2352 by 1568 pixels. Retinal fundus photograph
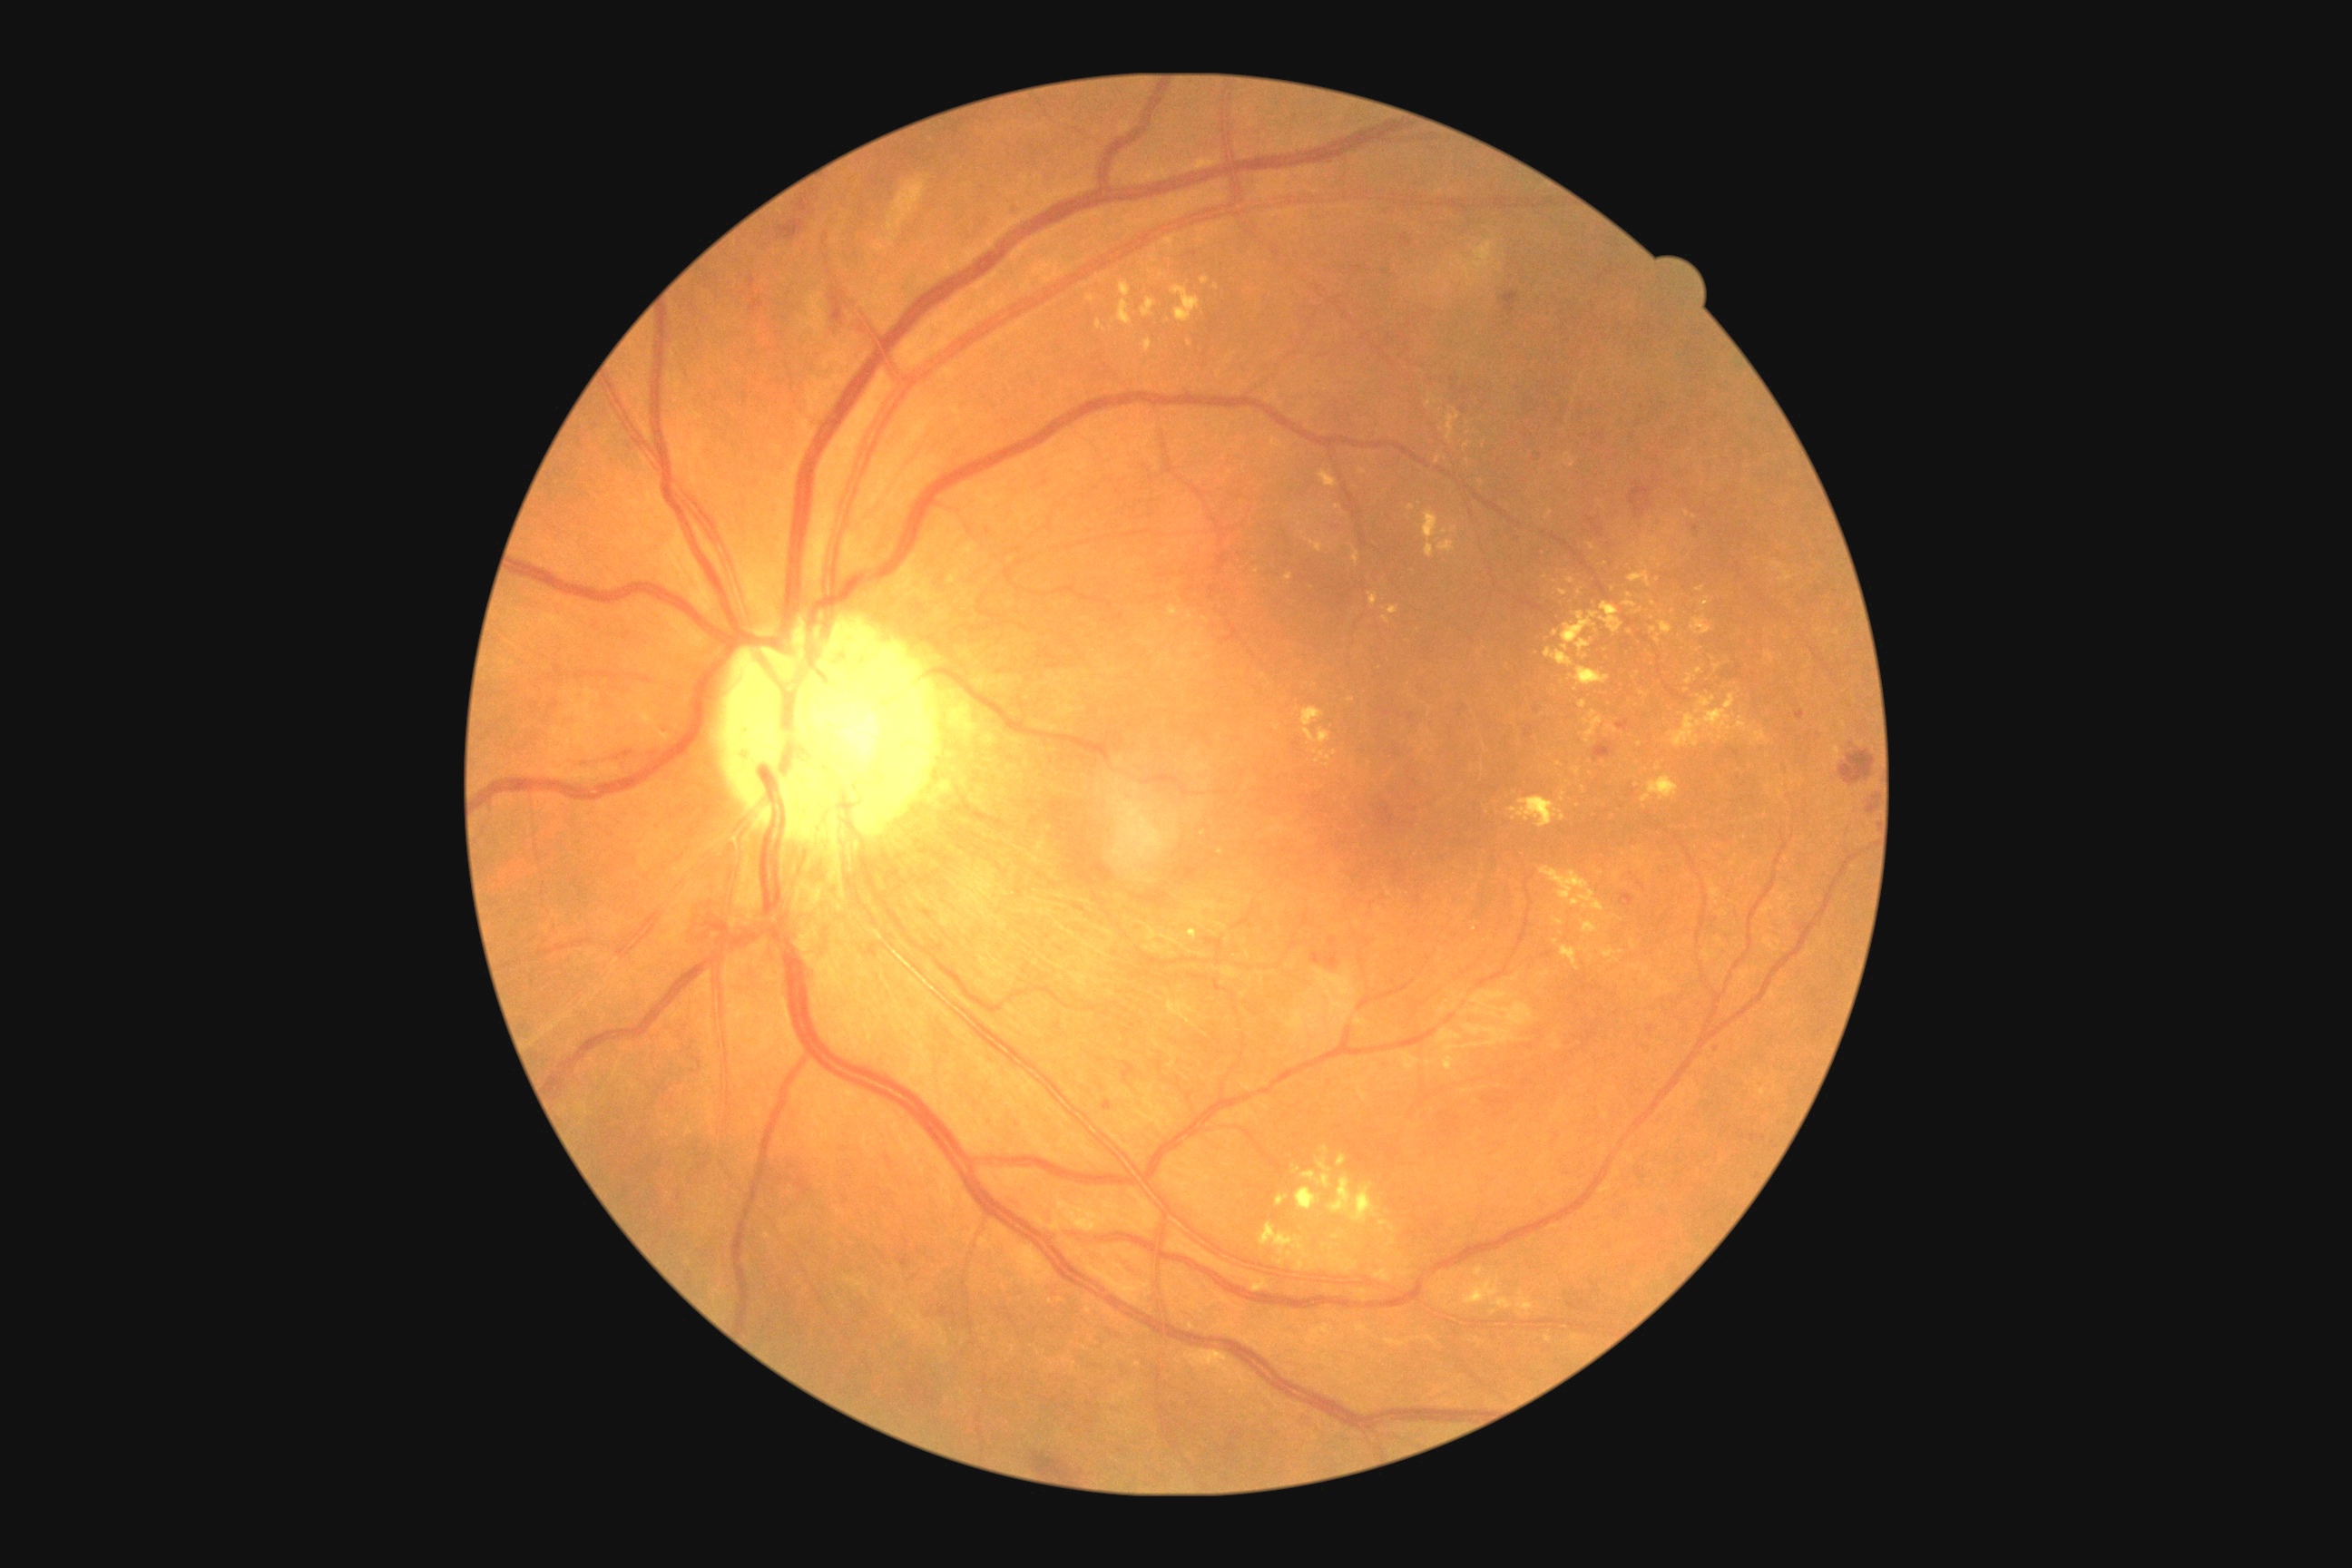 Diabetic retinopathy (DR) is moderate non-proliferative diabetic retinopathy (grade 2)
A subset of detected lesions:
hard exudates (EXs) (continued) = (x1=1186, y1=612, x2=1193, y2=622); (x1=1690, y1=618, x2=1712, y2=636); (x1=1464, y1=1279, x2=1513, y2=1309); (x1=1558, y1=453, x2=1576, y2=467); (x1=1426, y1=544, x2=1435, y2=558); (x1=1277, y1=1195, x2=1289, y2=1208); (x1=1475, y1=1268, x2=1484, y2=1279); (x1=1583, y1=710, x2=1603, y2=745); (x1=1378, y1=1220, x2=1389, y2=1228); (x1=1631, y1=939, x2=1636, y2=950)
Small EXs near [1221,851]; [1658,580]; [1216,288]; [1555,942]; [1454,530]; [1162,277]; [1467,462]; [1428,403]; [1583,789]